Clarity RetCam 3, 130° FOV · wide-field contact fundus photograph of an infant.
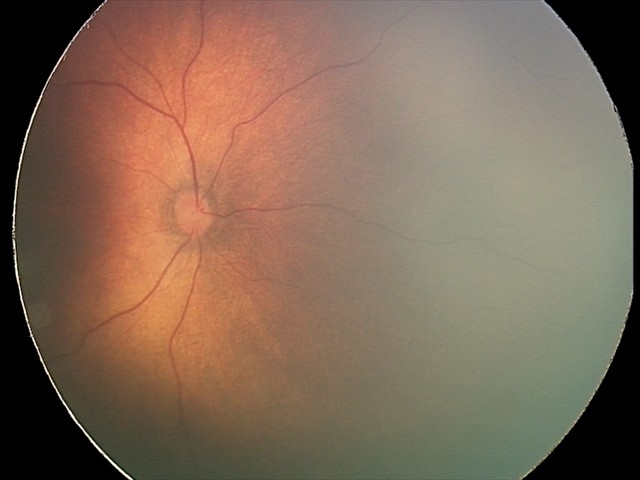 Screening series with status post retinopathy of prematurity (ROP). Plus disease absent.